2352 x 1568 pixels, 45° FOV
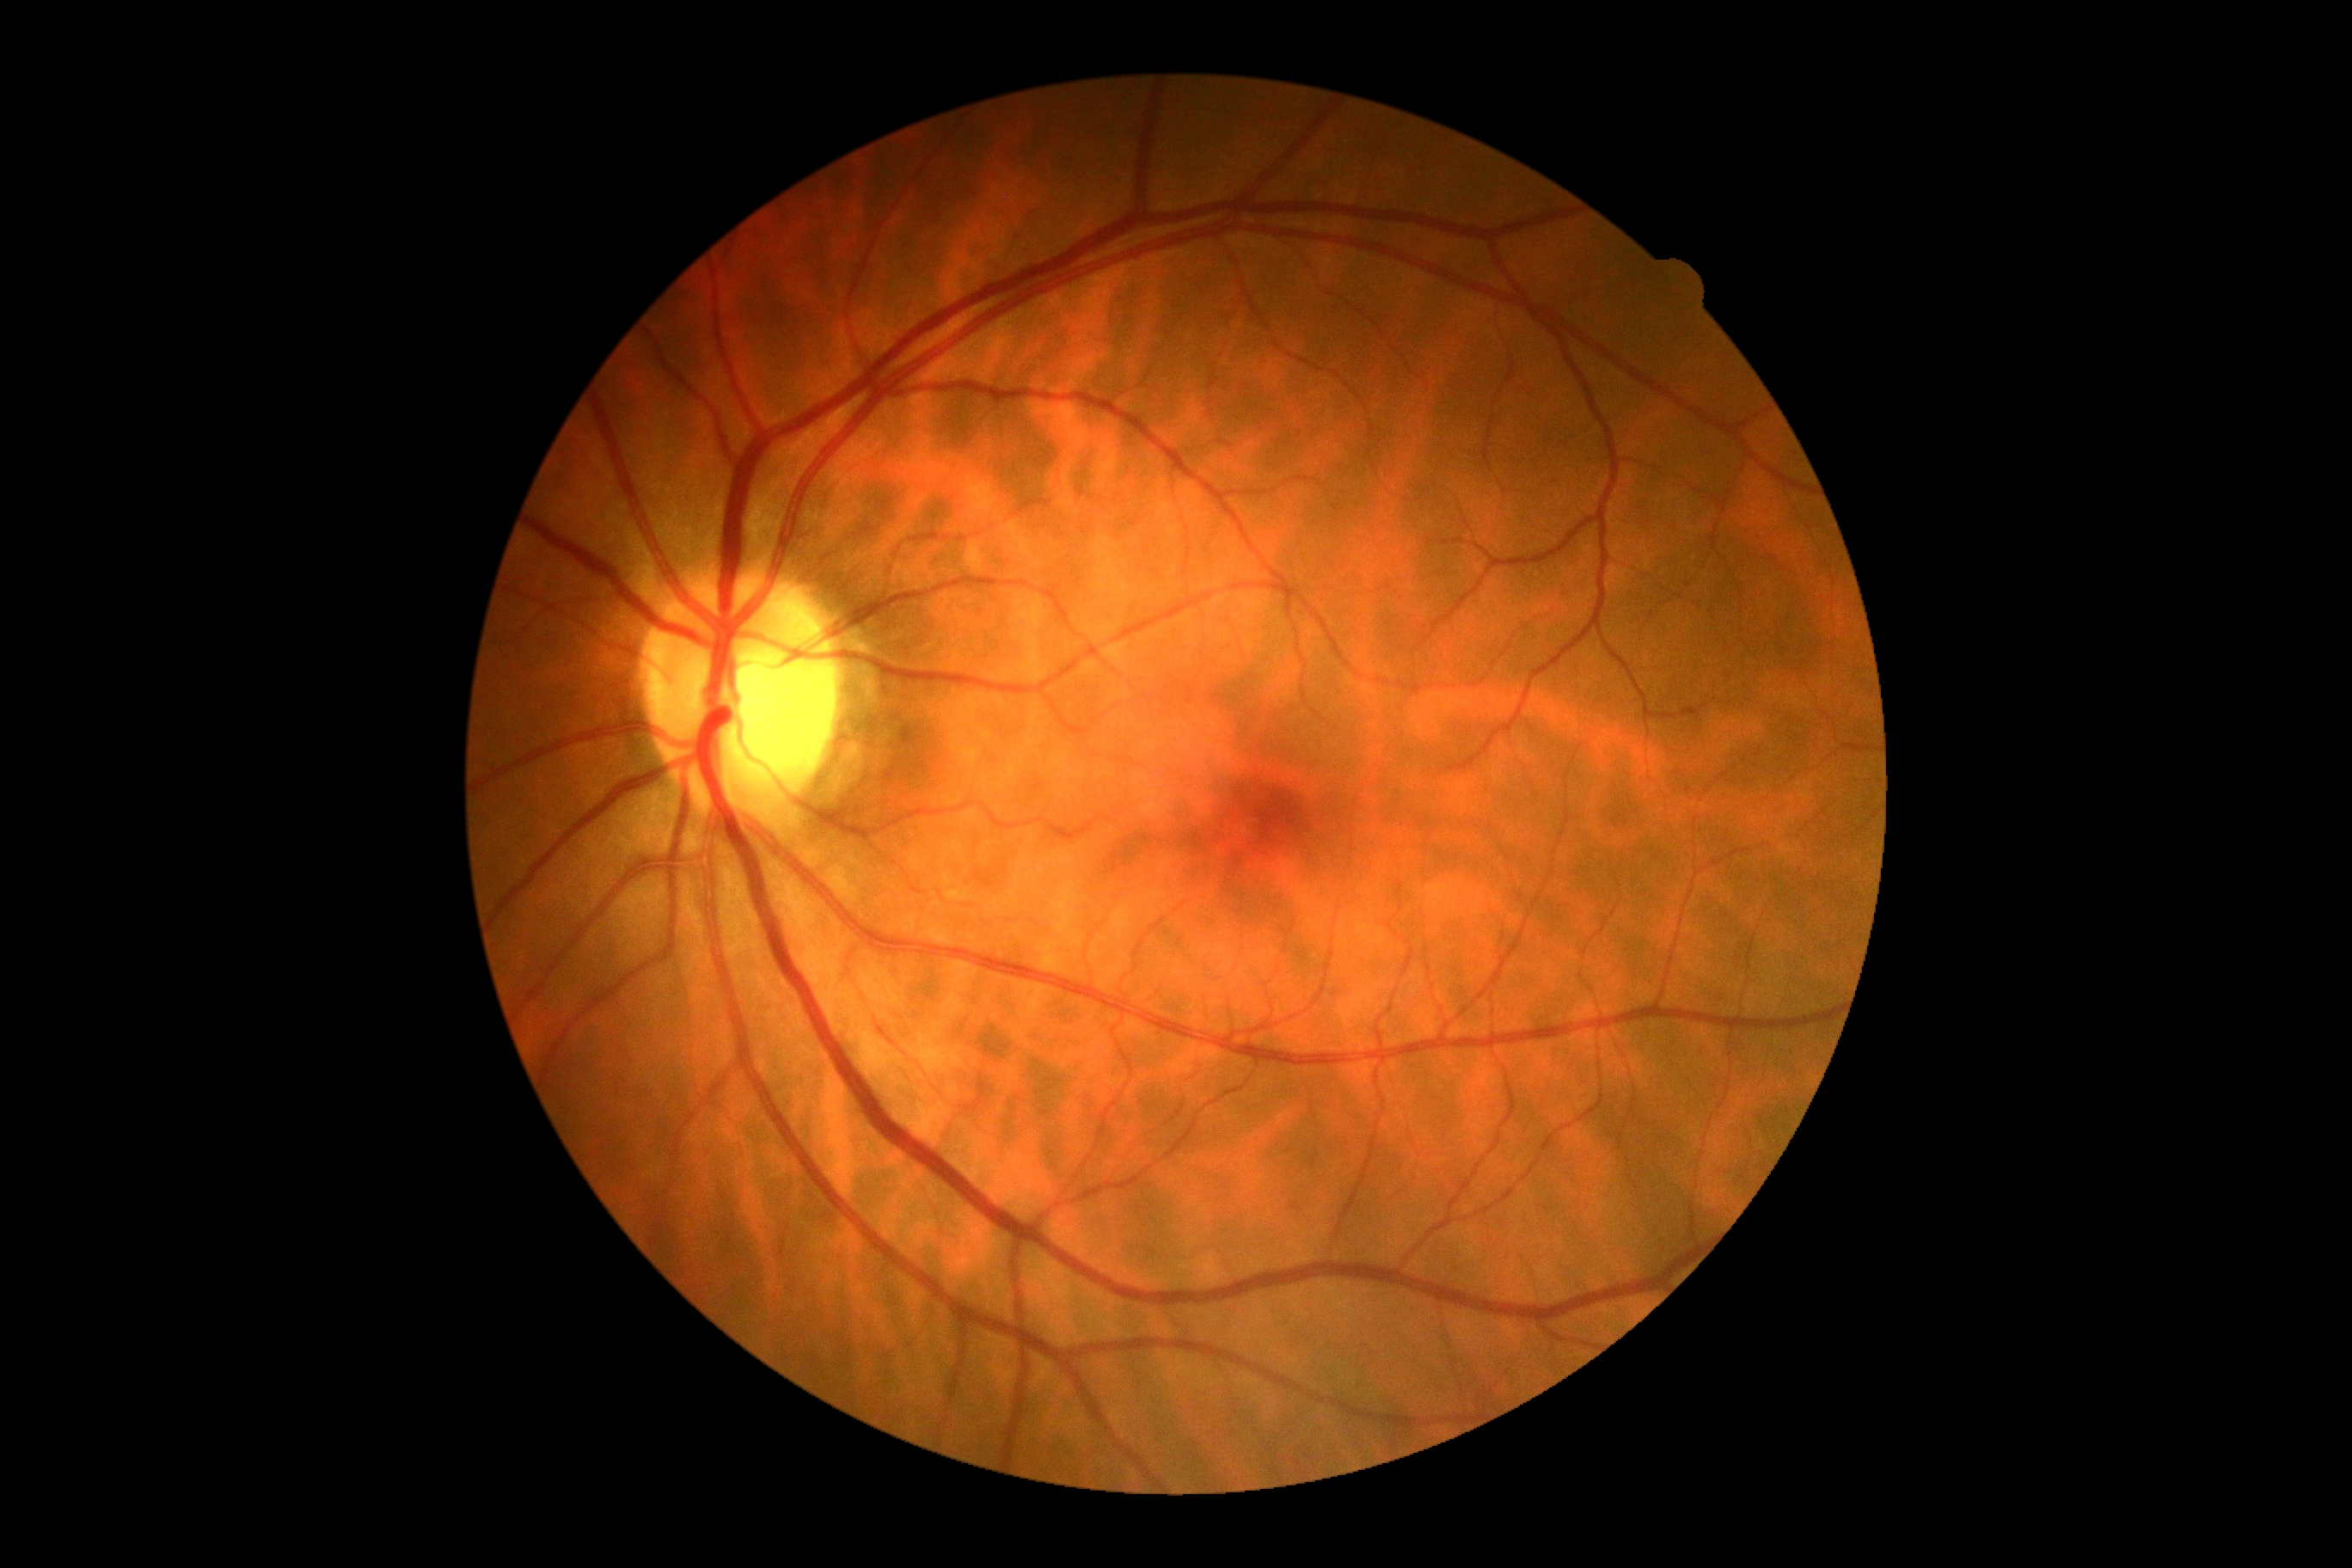
DR grade: no apparent diabetic retinopathy (0).